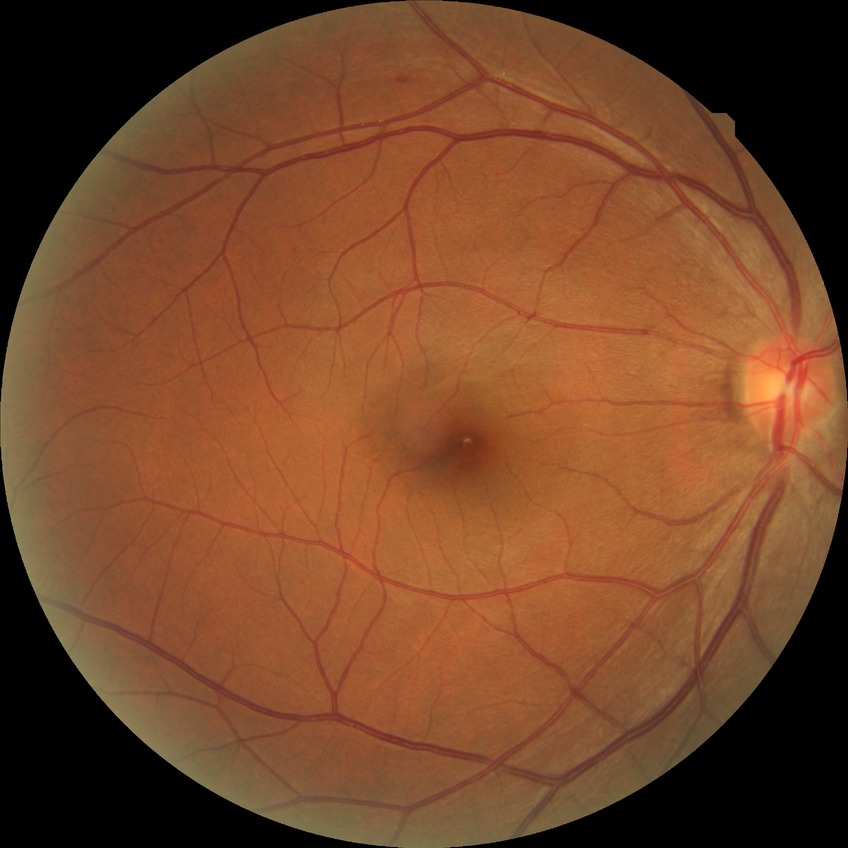
DR impression = negative for DR, DR stage = NDR.